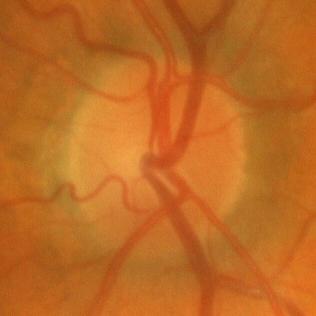 Finding: no glaucomatous changes.